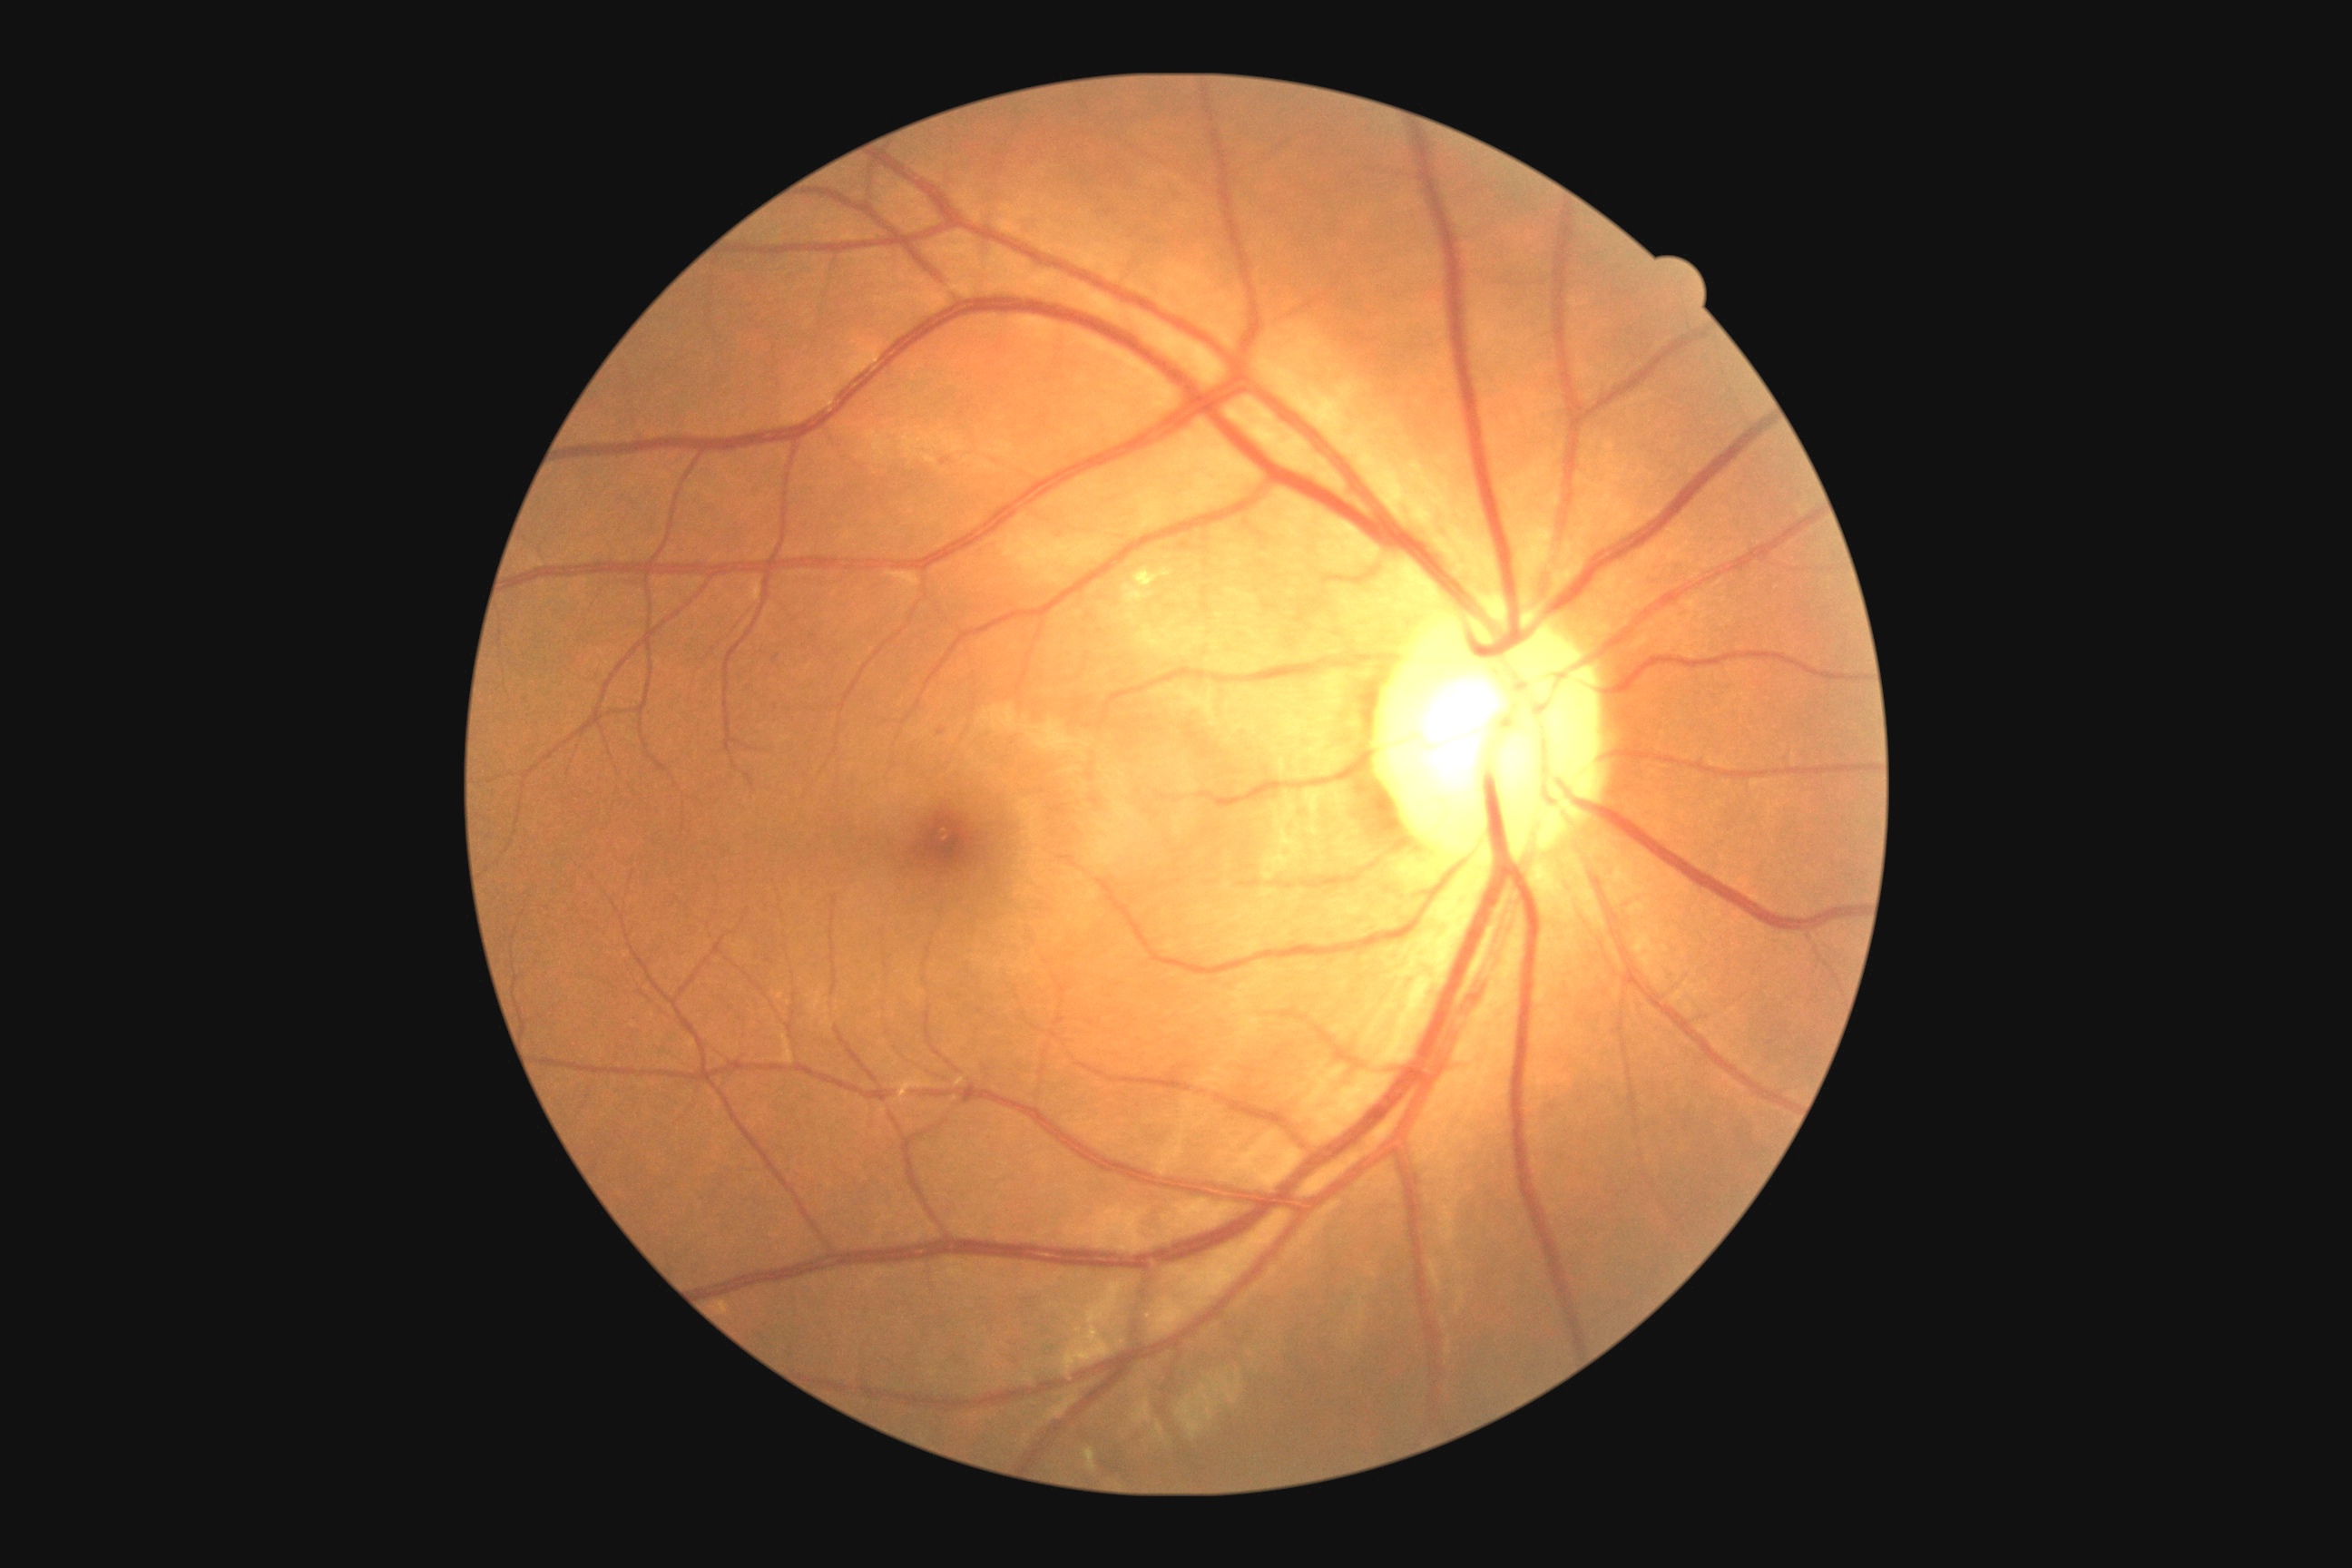
The retinopathy is classified as non-proliferative diabetic retinopathy.
Diabetic retinopathy: grade 2.